30° FOV; autorefraction: +1 -3 x 87: 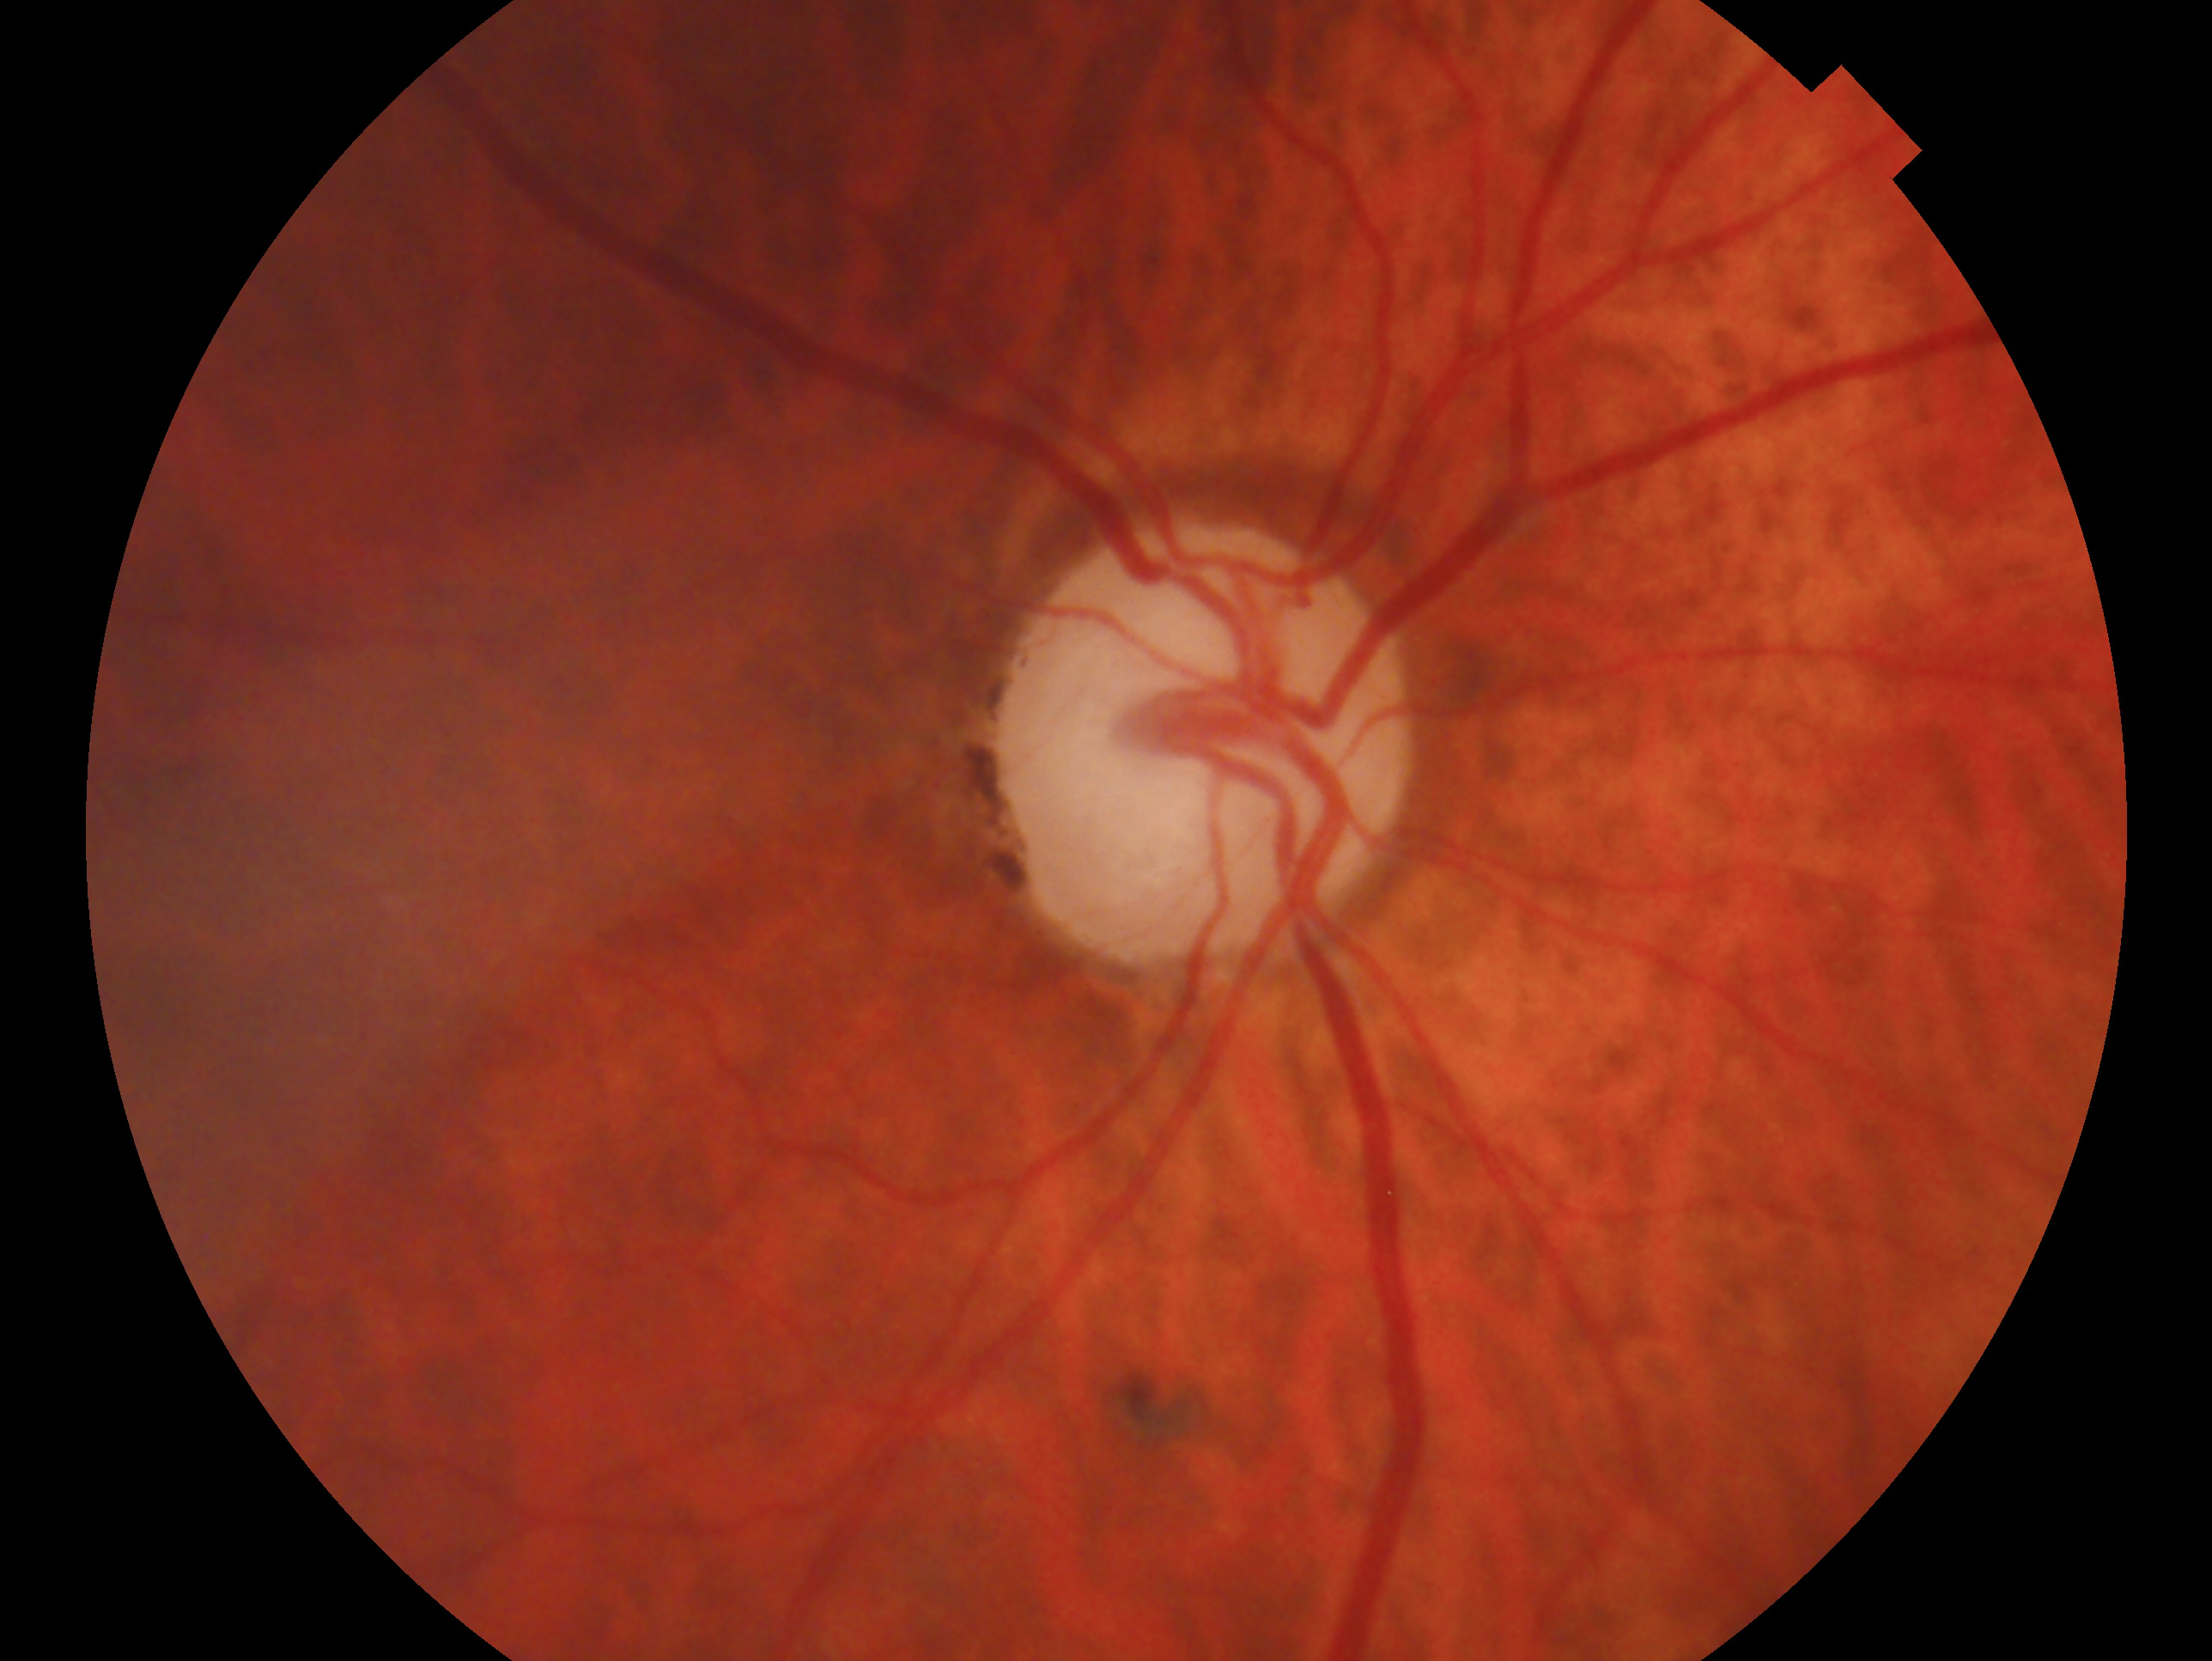
This is the right eye.
Impression — glaucoma.